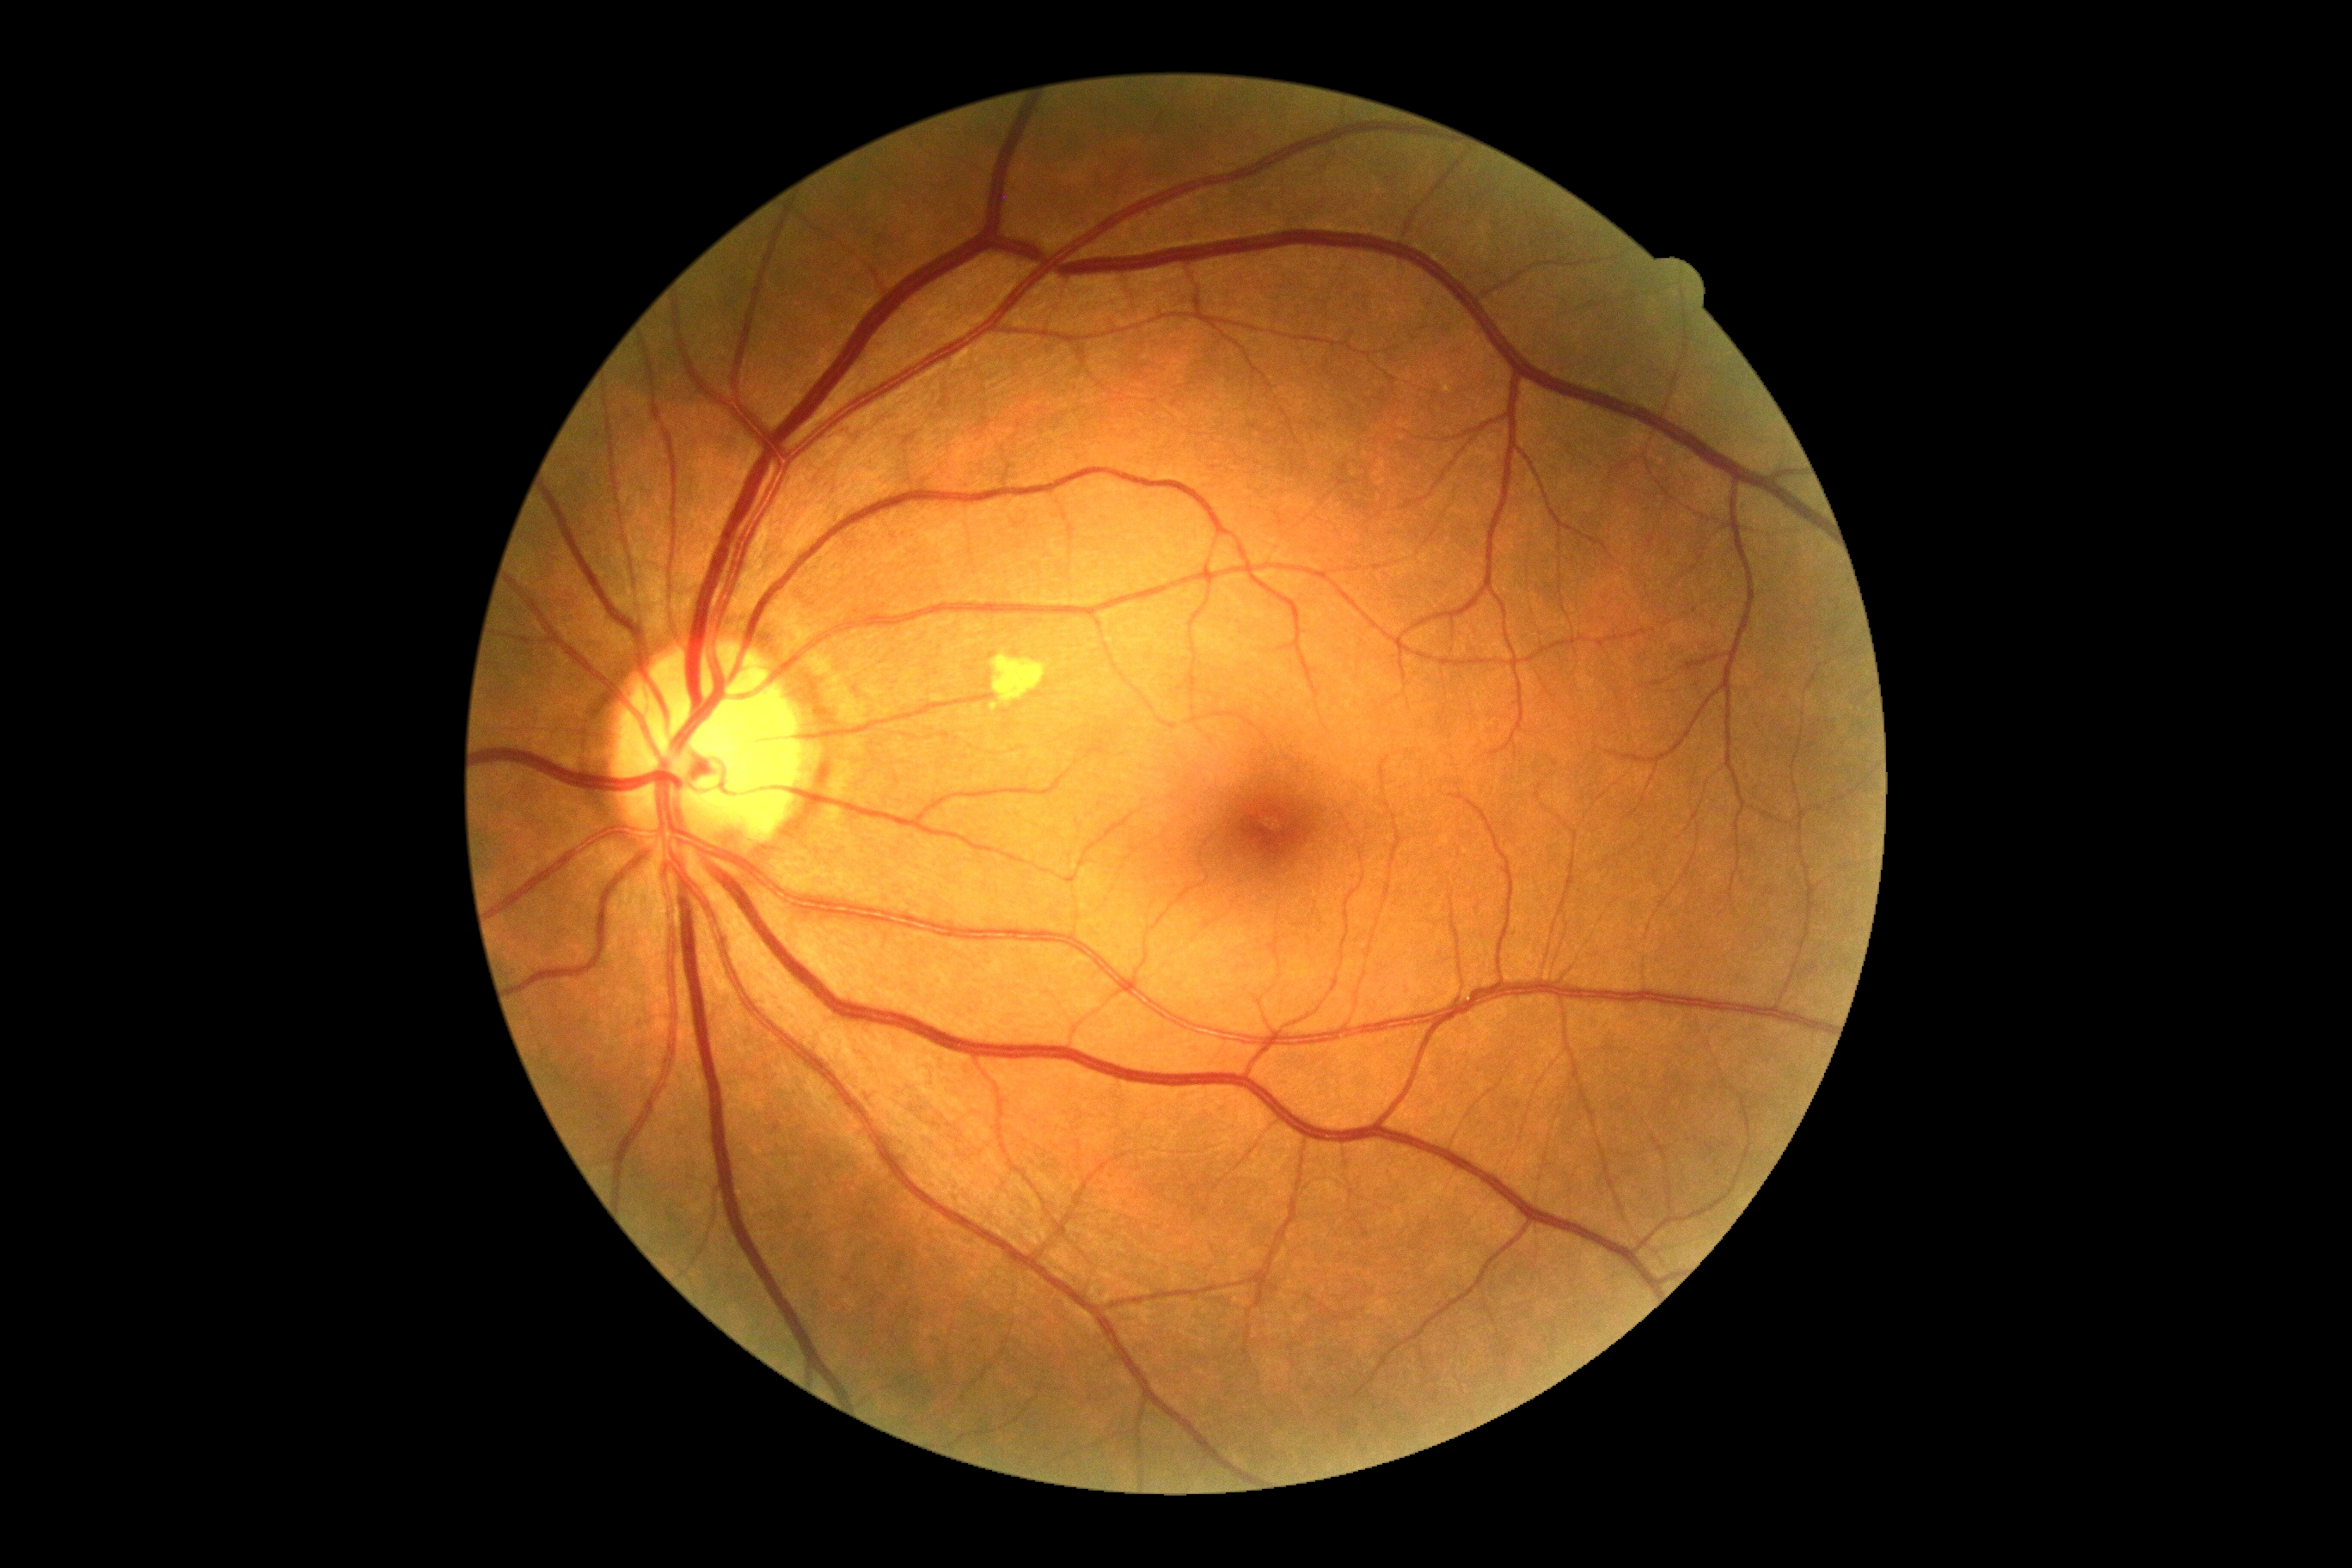

{"dr_grade": "grade 0"}